Without pupil dilation; modified Davis classification — 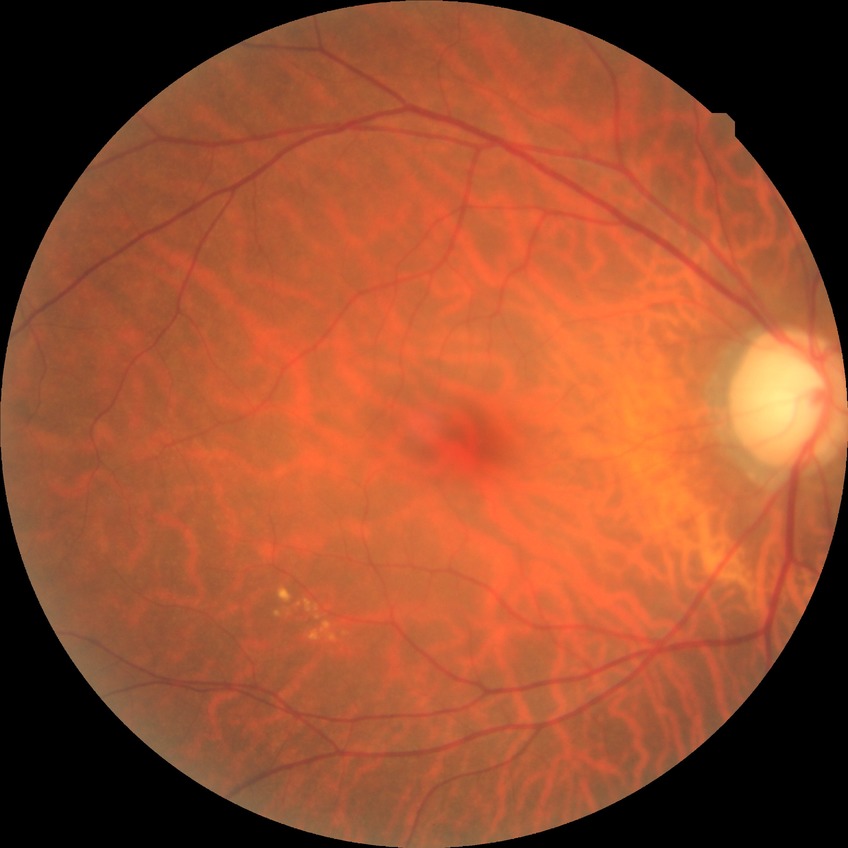
Diabetic retinopathy (DR) is NDR (no diabetic retinopathy).